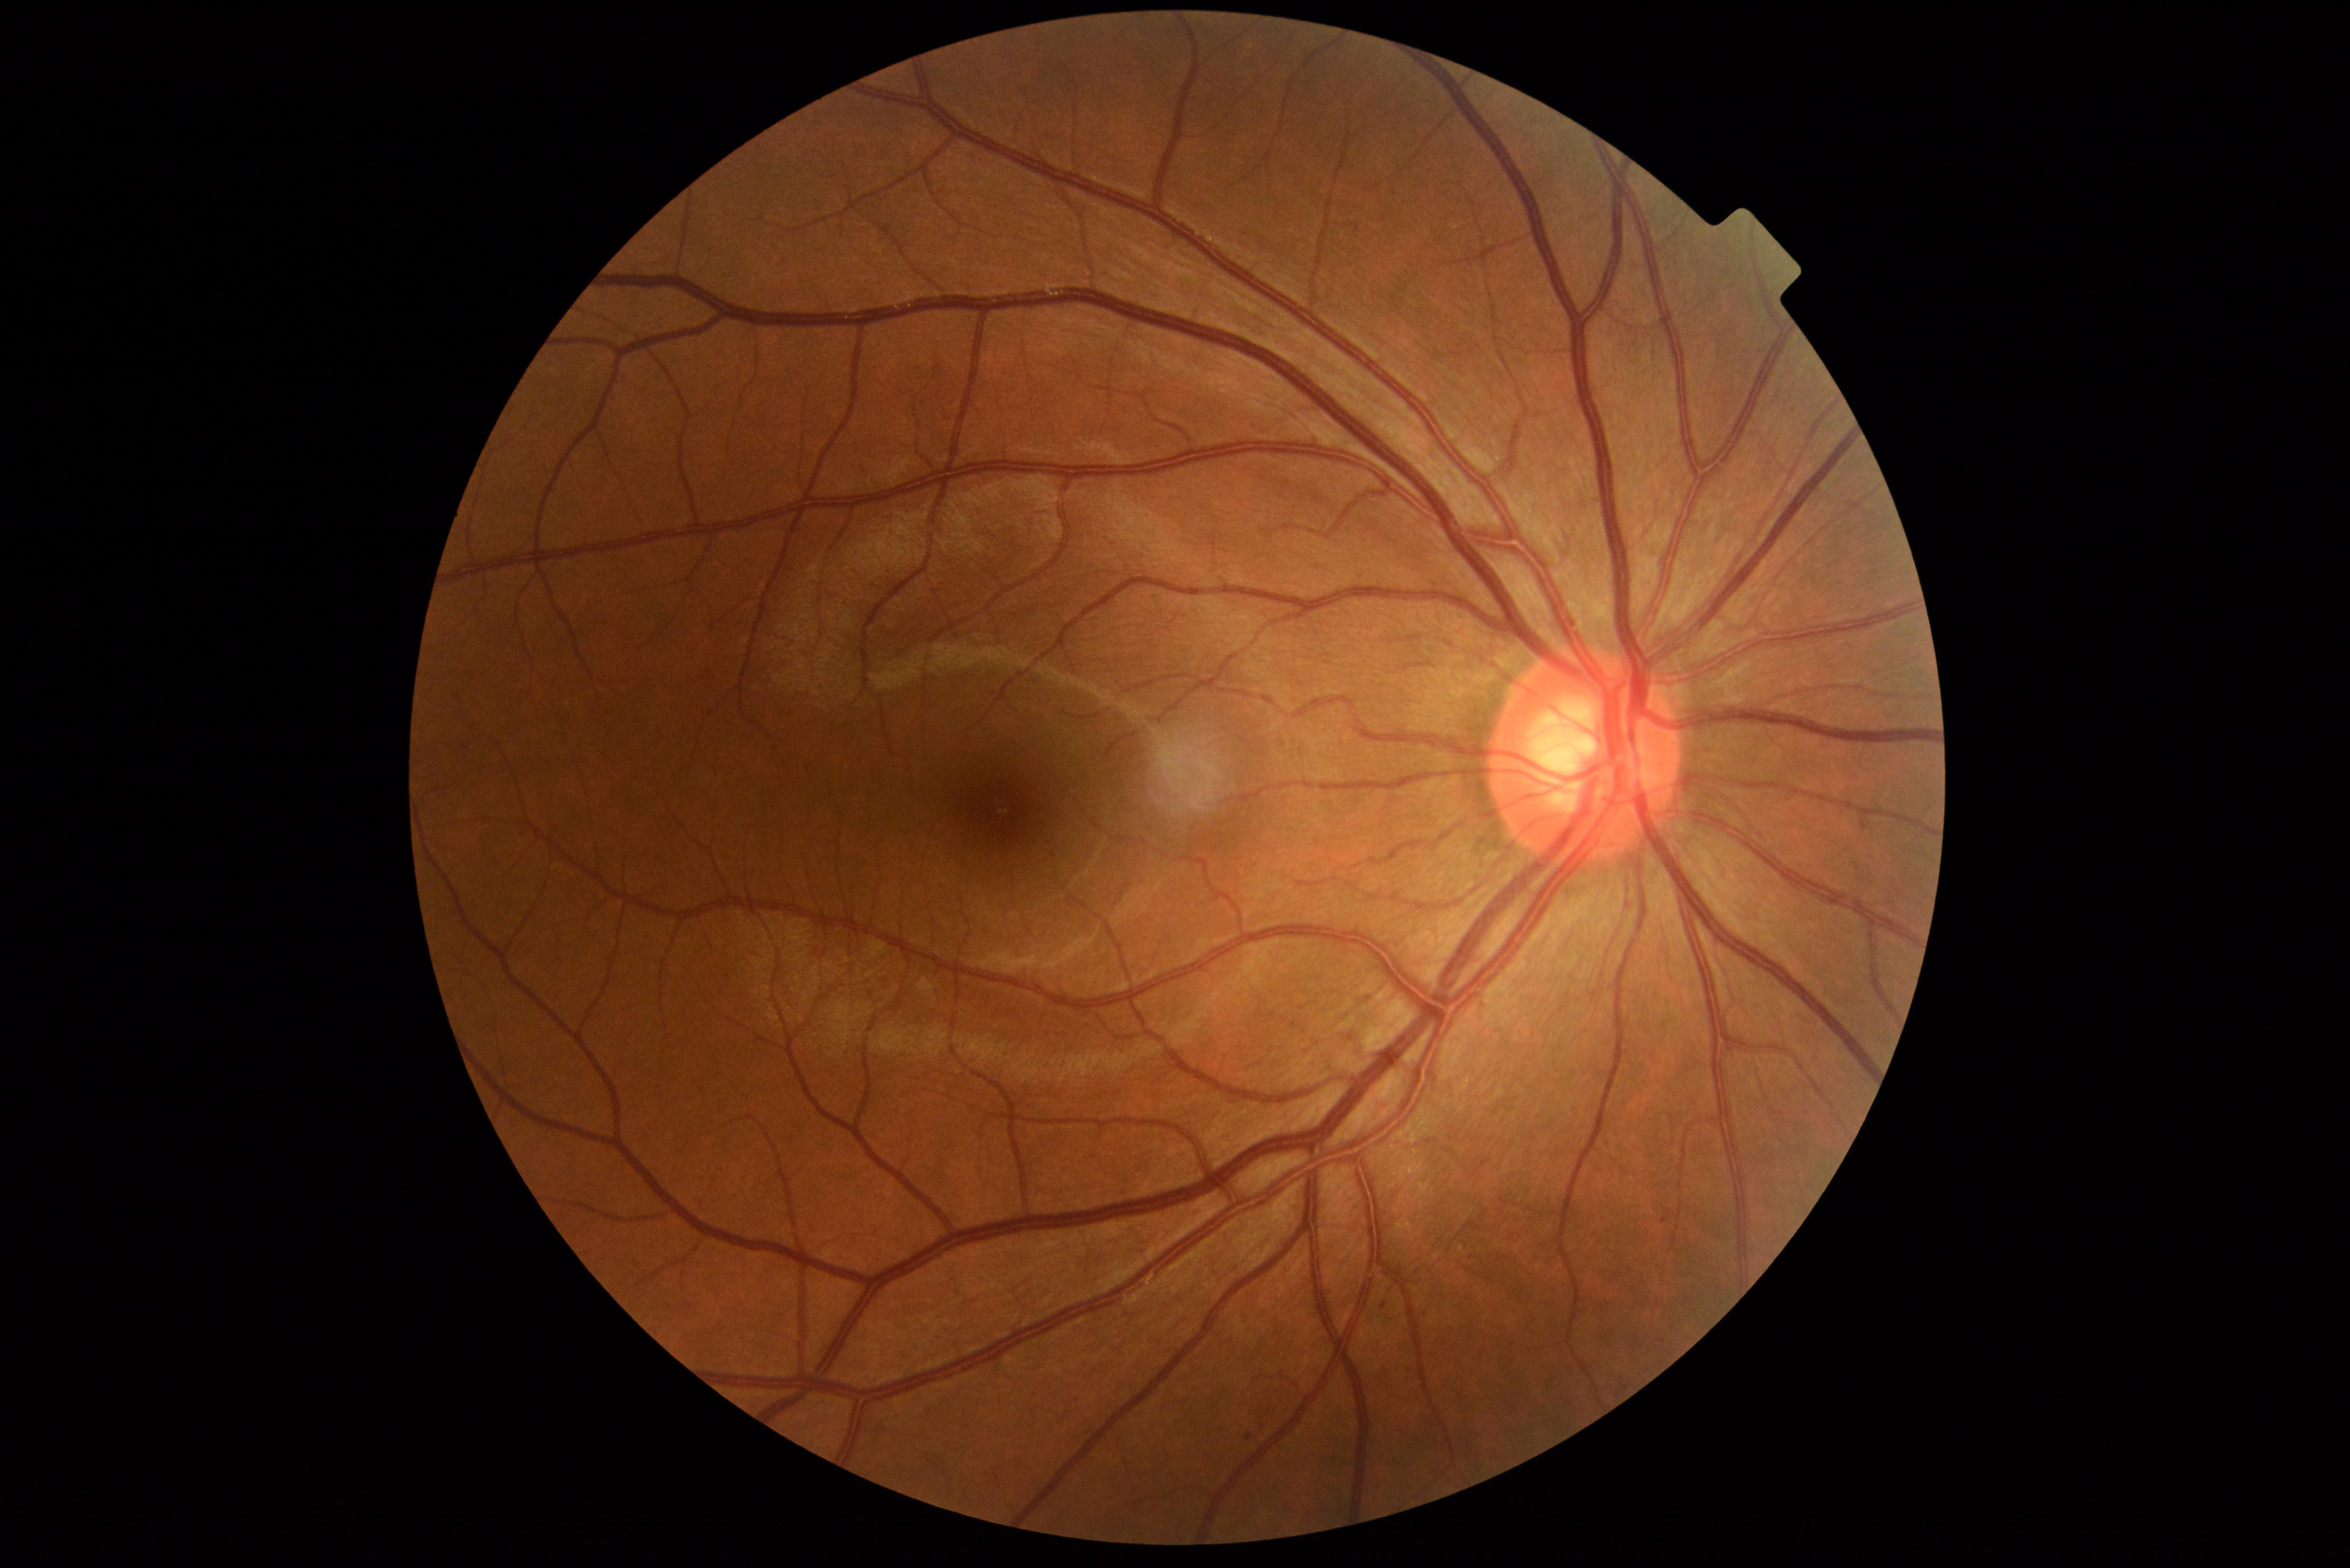

DR severity: mild non-proliferative diabetic retinopathy (grade 1).